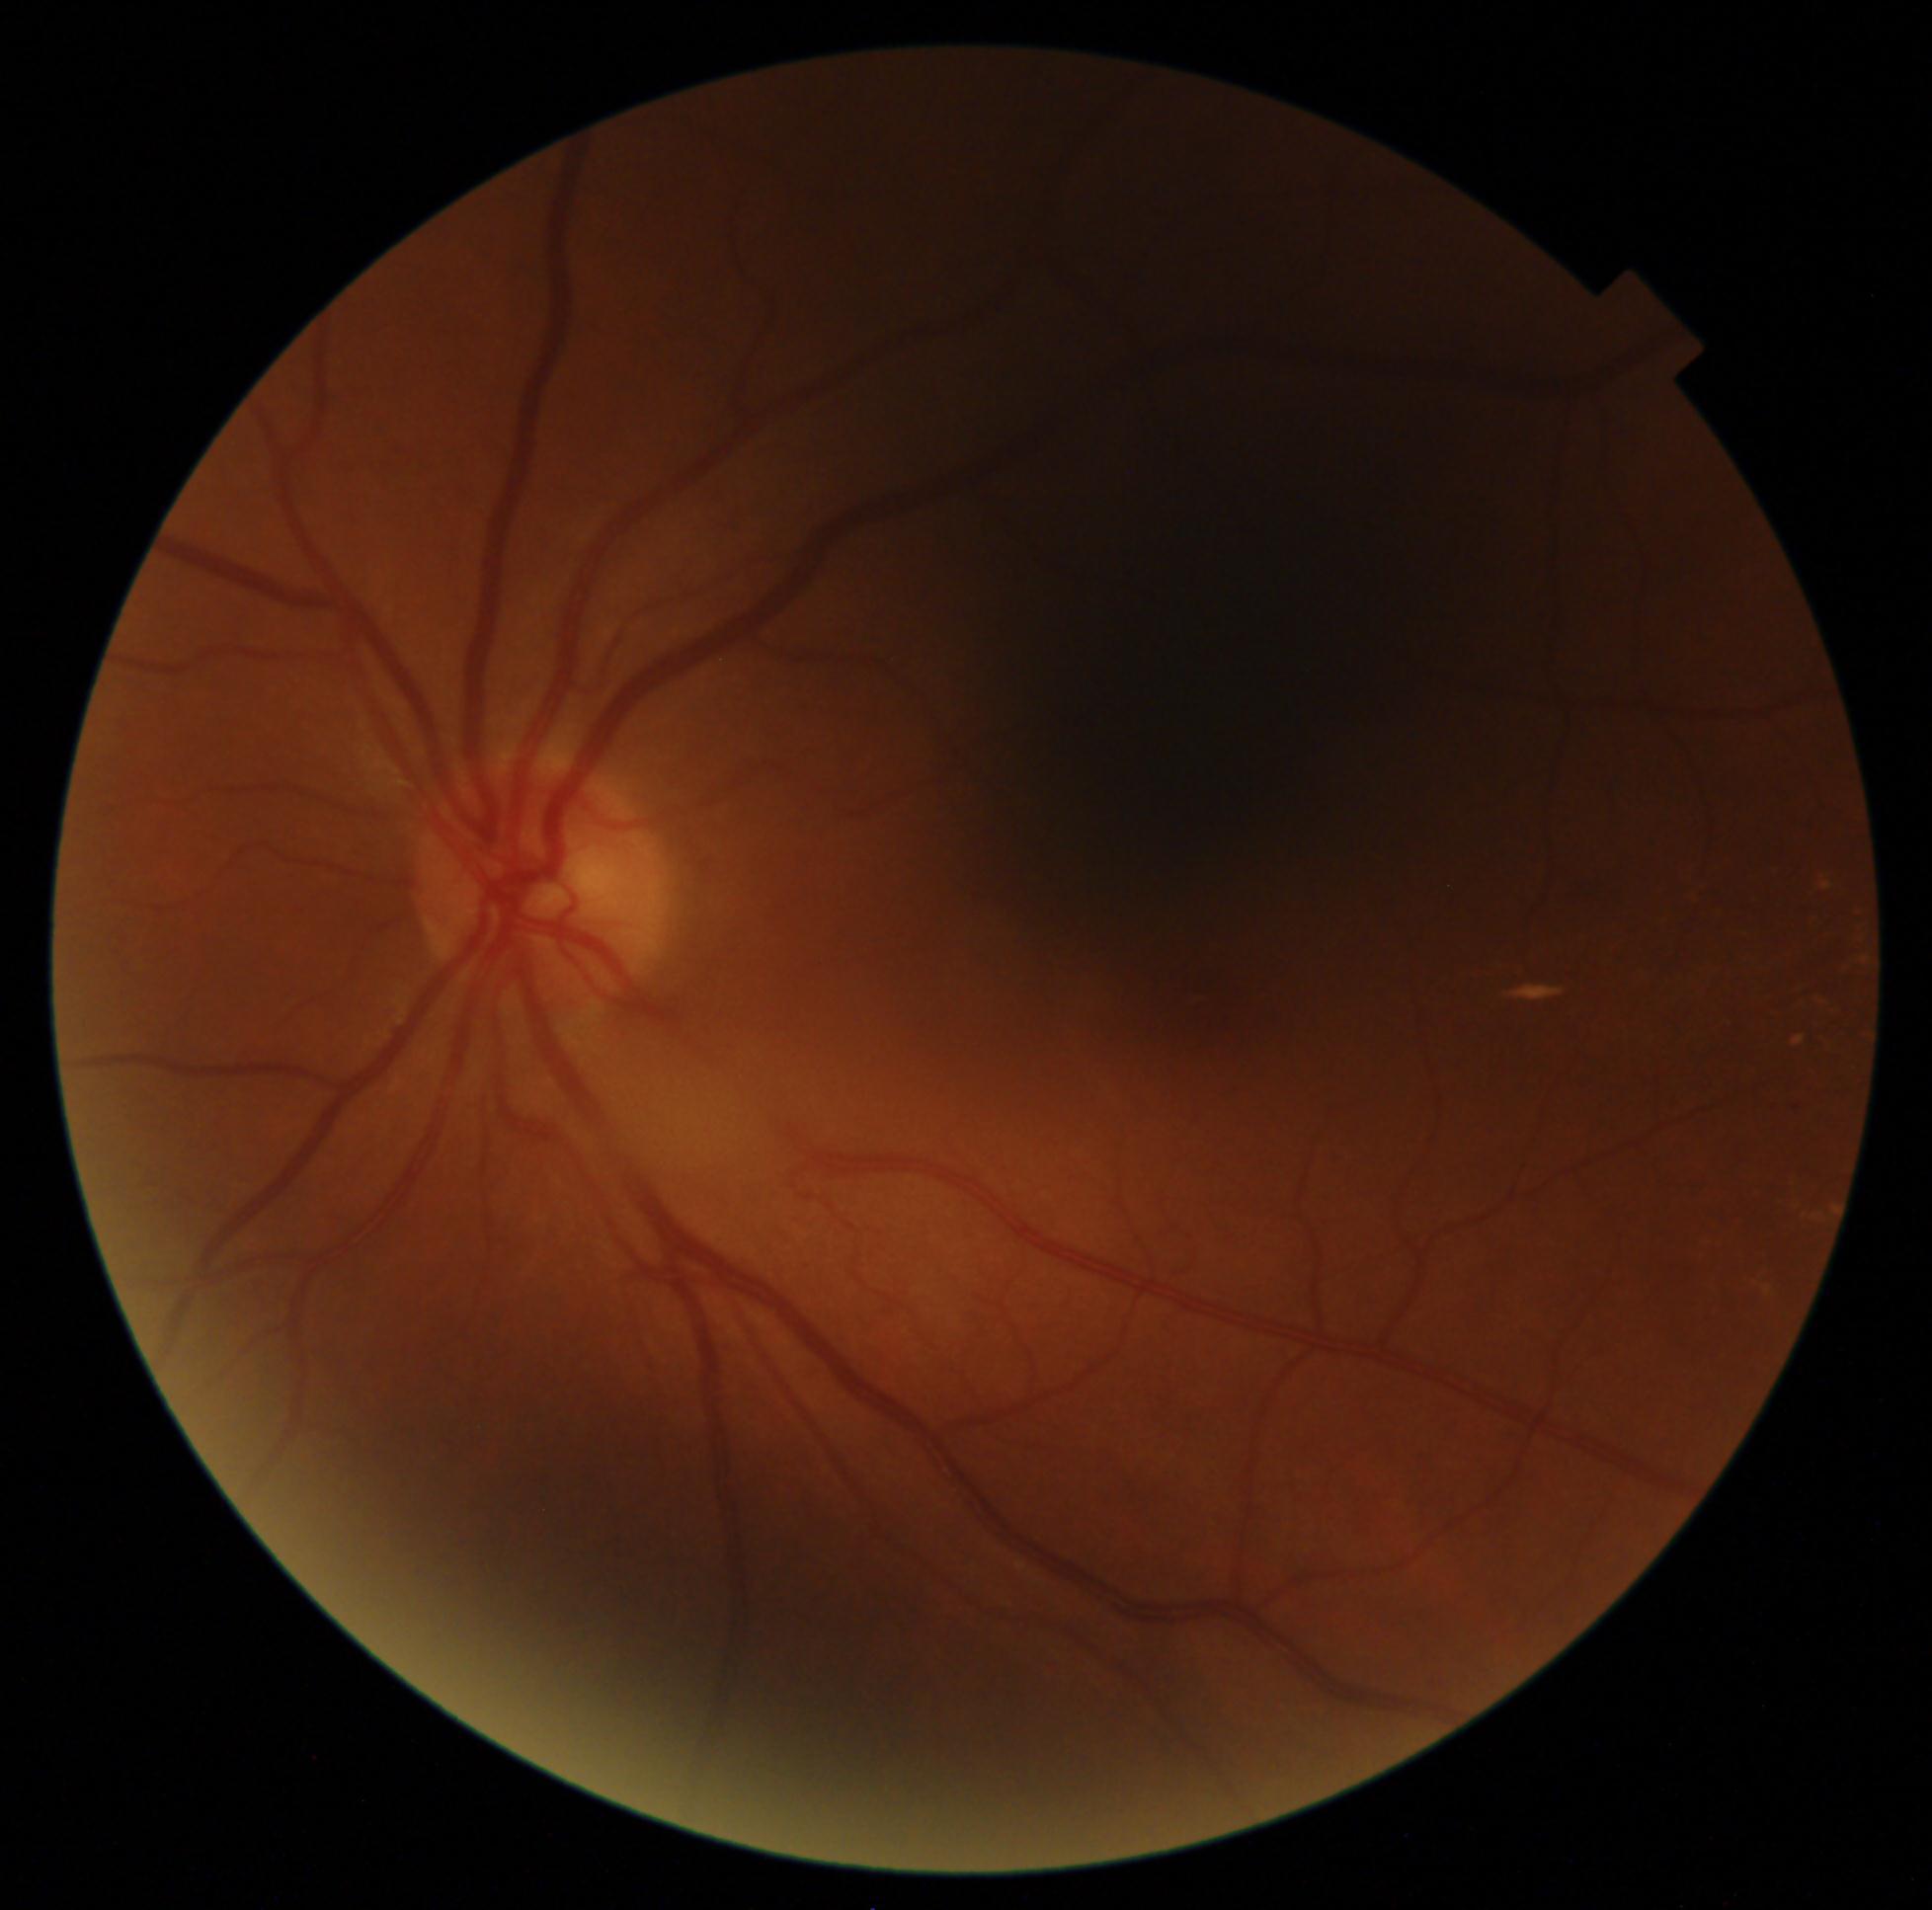 Annotations:
• DR class: non-proliferative diabetic retinopathy
• diabetic retinopathy severity: 2 — more than just microaneurysms but less than severe NPDR